Wide-field fundus image from infant ROP screening: 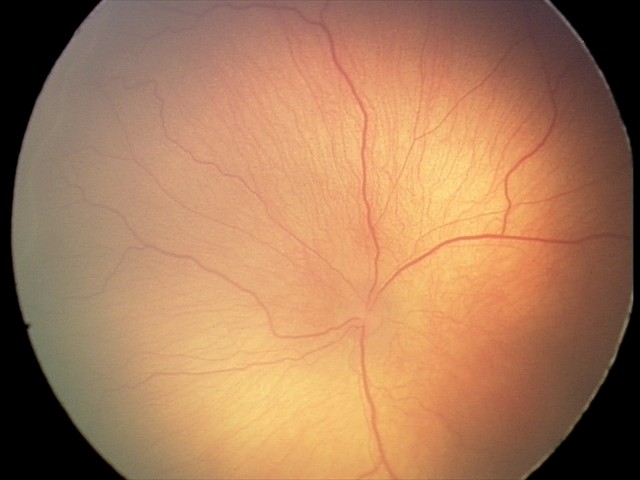
Examination diagnosed as retinopathy of prematurity stage 1.
Plus disease absent.